412x310px:
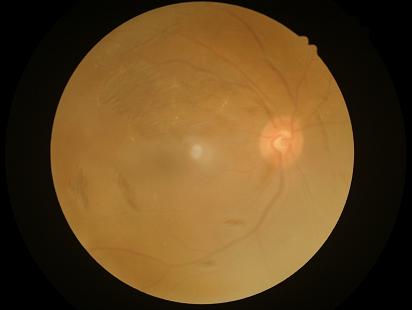
Image quality: clarity: out of focus | contrast: poor | overall: poor | illumination: poor.